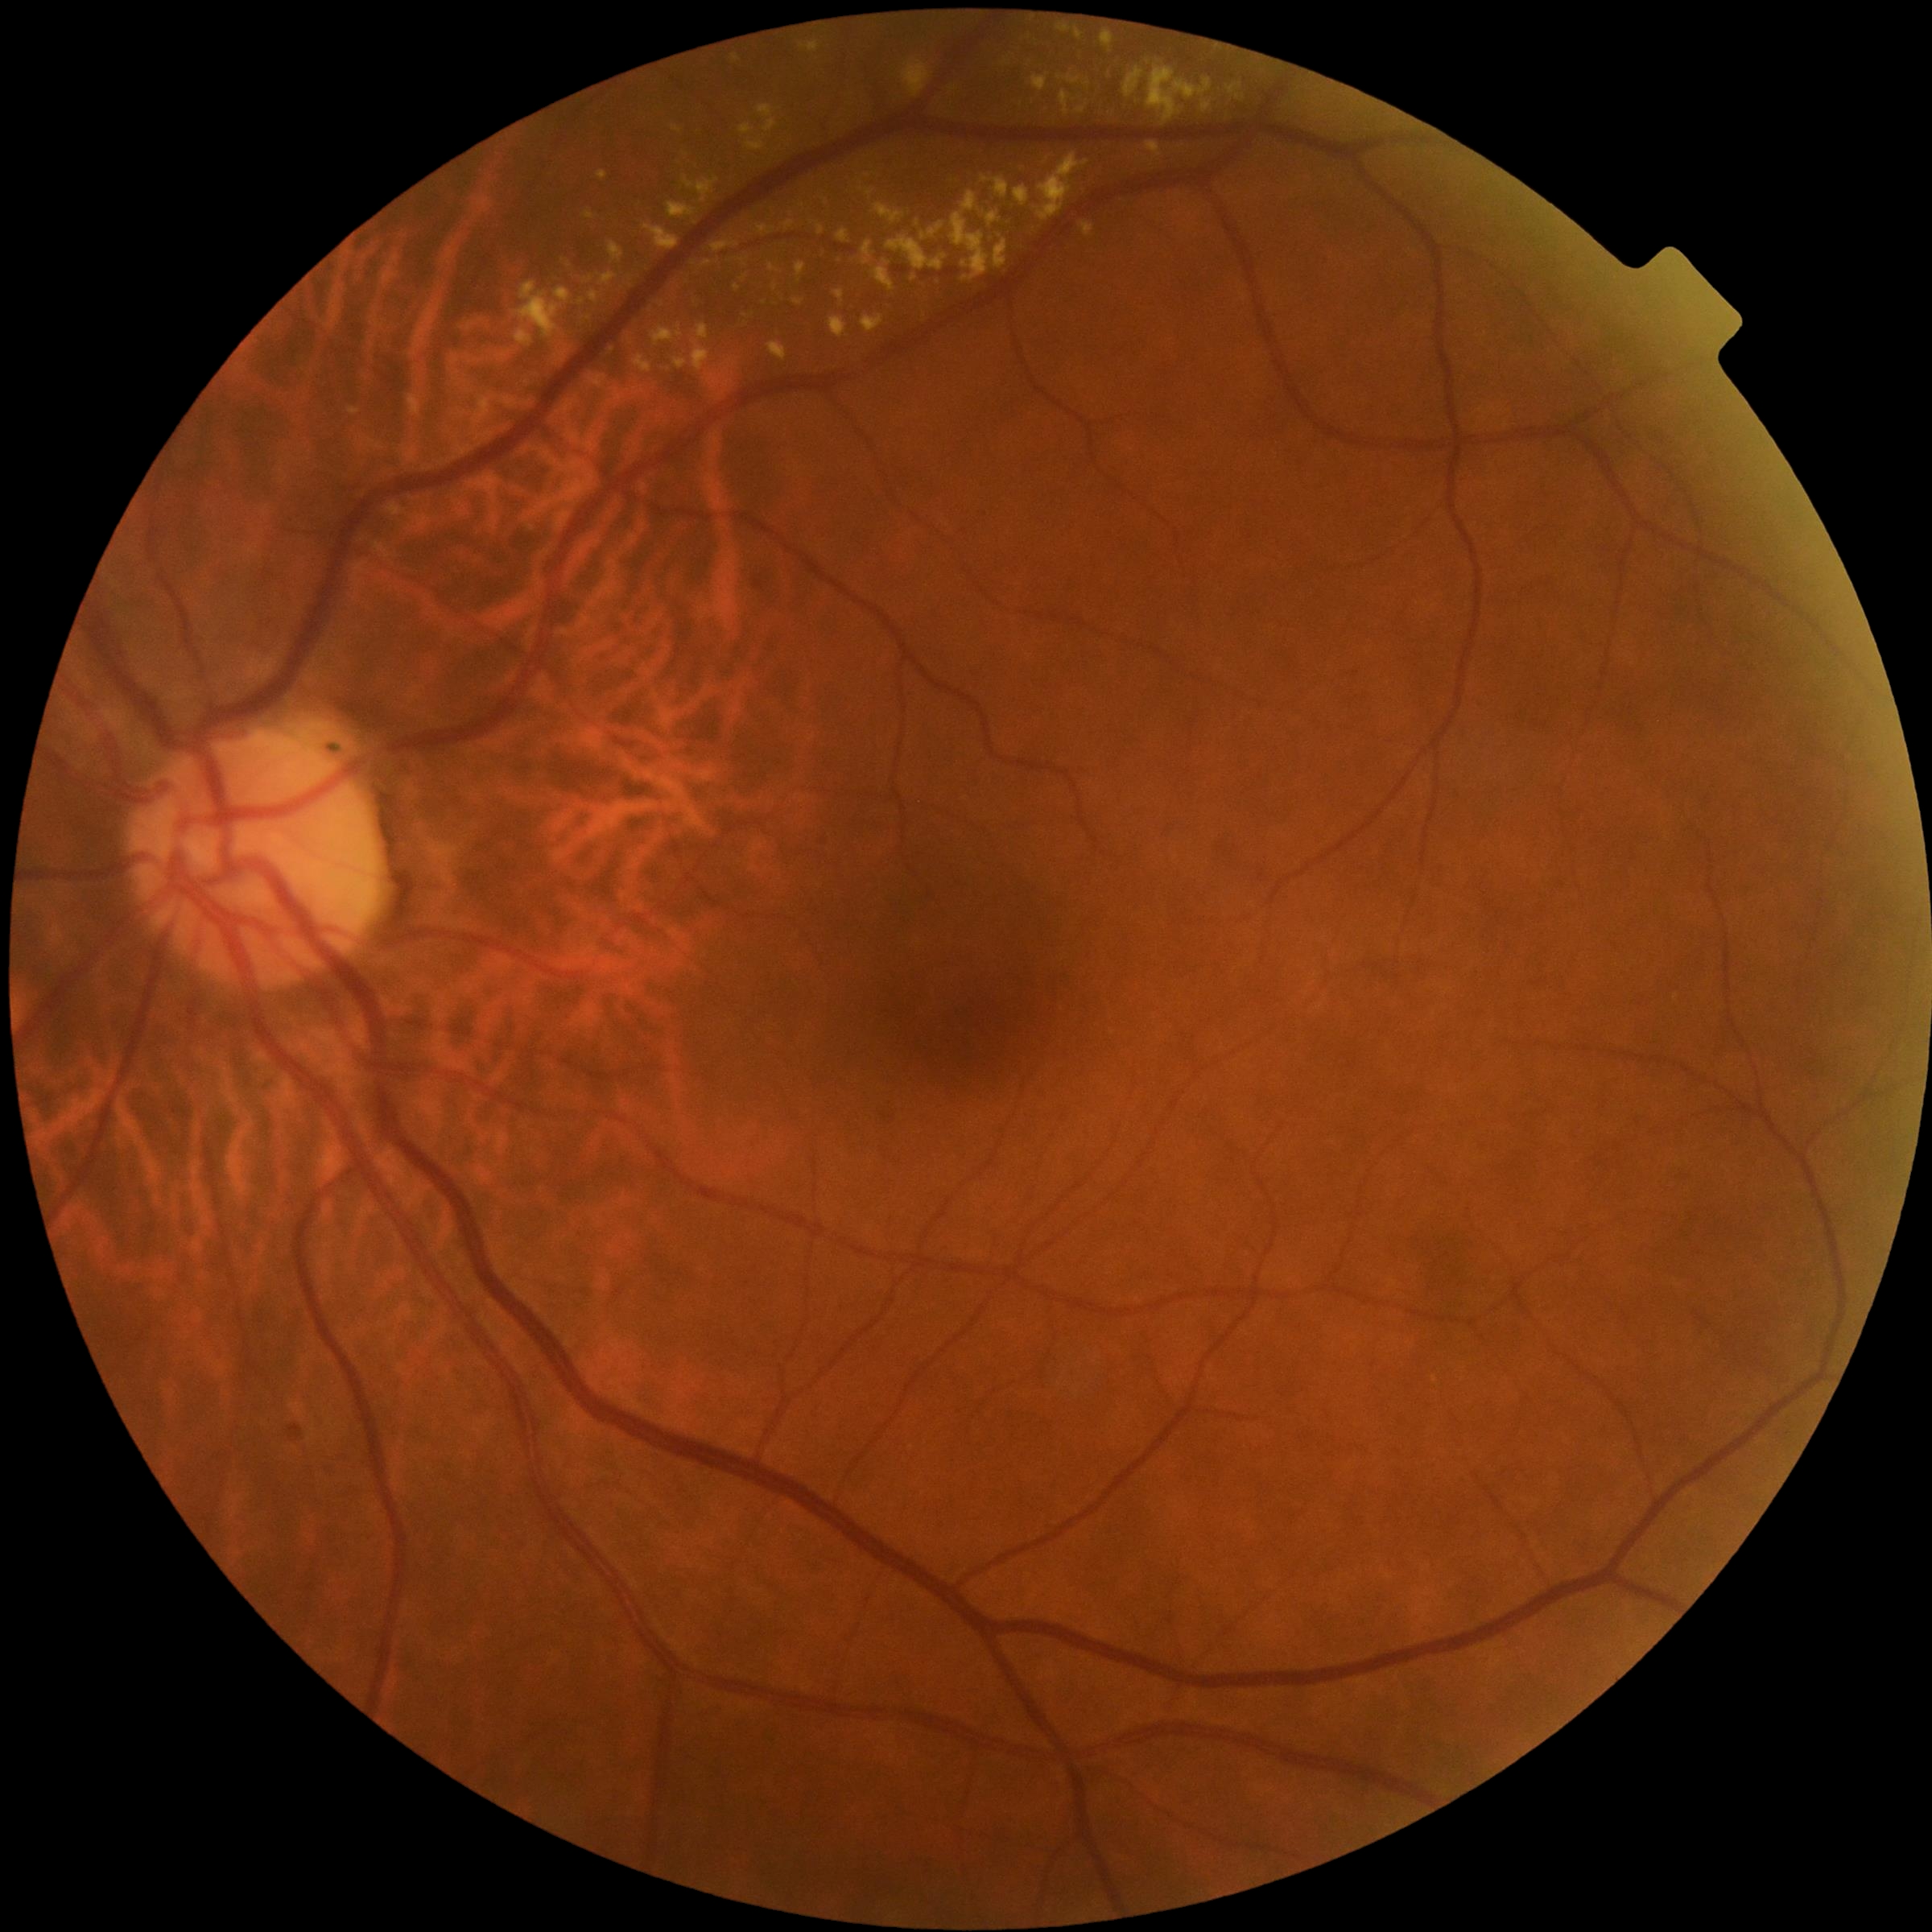 Diabetic retinopathy grade: 2
A subset of detected lesions:
hard exudates (partial) = [left=597, top=171, right=609, bottom=180] | [left=1147, top=142, right=1162, bottom=157] | [left=674, top=358, right=689, bottom=369] | [left=920, top=223, right=947, bottom=242] | [left=609, top=242, right=625, bottom=262] | [left=375, top=544, right=392, bottom=559] | [left=733, top=54, right=740, bottom=64] | [left=712, top=242, right=740, bottom=253] | [left=1147, top=61, right=1213, bottom=126] | [left=873, top=204, right=907, bottom=225] | [left=497, top=351, right=510, bottom=362] | [left=817, top=225, right=824, bottom=236] | [left=683, top=176, right=719, bottom=204] | [left=795, top=300, right=803, bottom=306]
Small hard exudates approximately at <point>1007, 63</point> | <point>826, 201</point> | <point>737, 289</point>